Image size 2048x1536. 45° field of view: 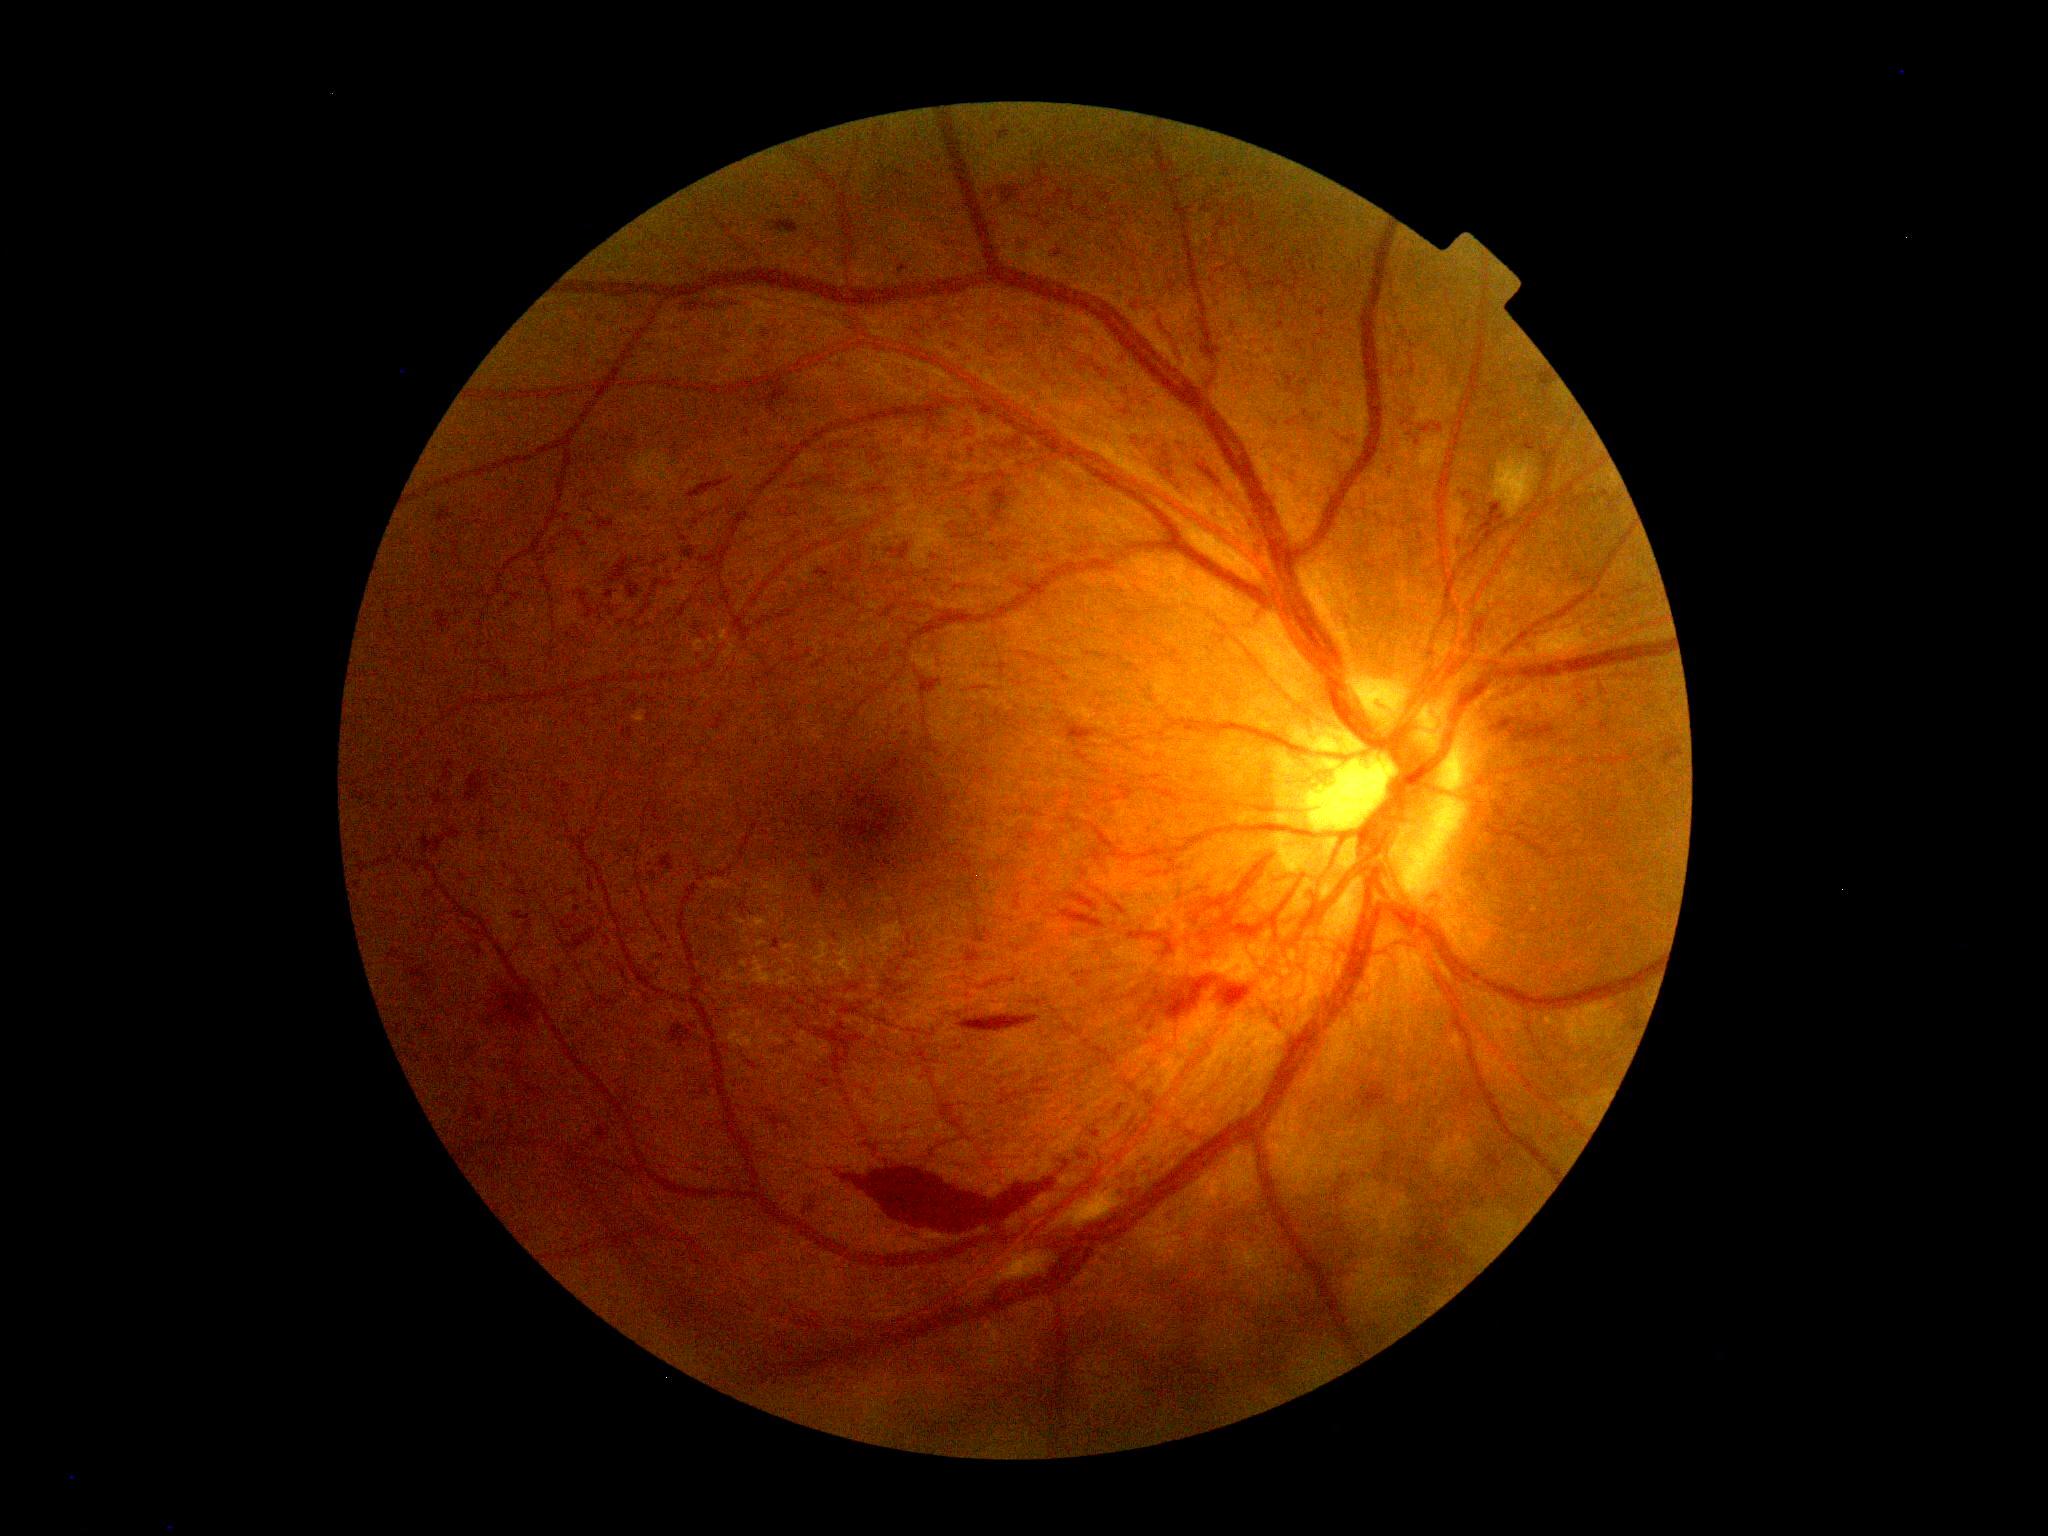
DR: grade 4 (PDR). DR class: proliferative diabetic retinopathy.